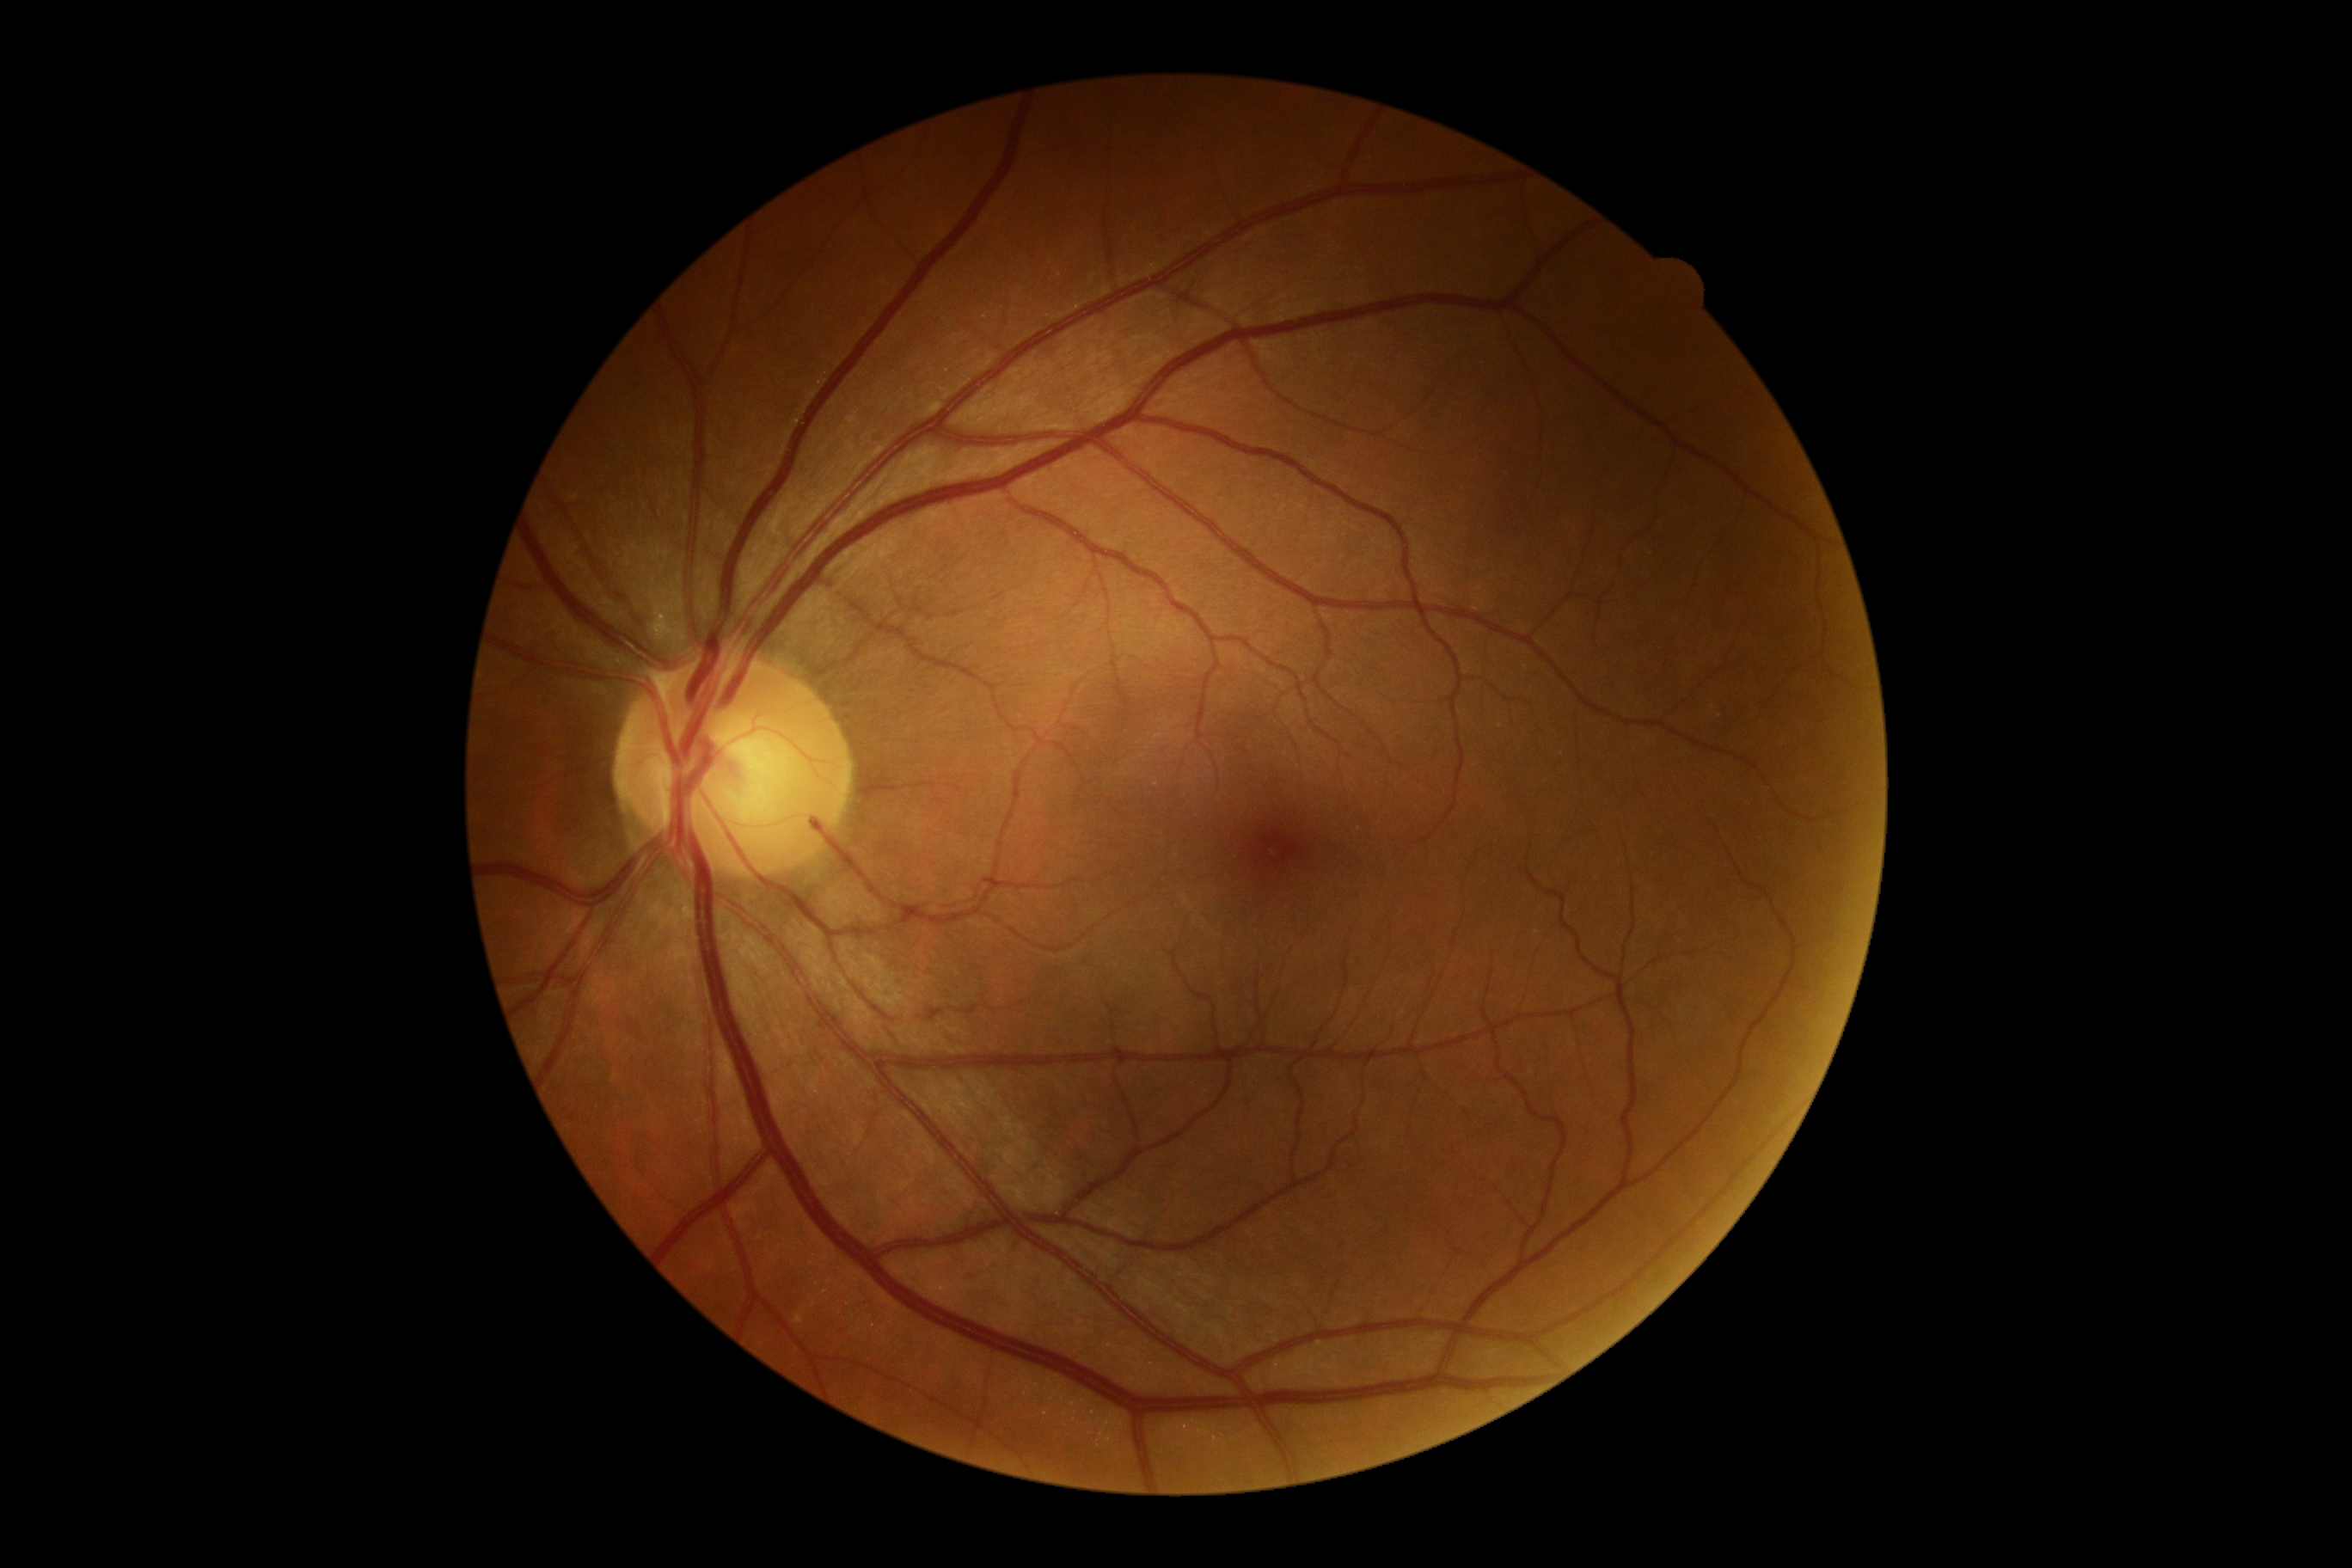 dr_grade: 0
dr_impression: no signs of DR